45° field of view. Image size 2352x1568. CFP: 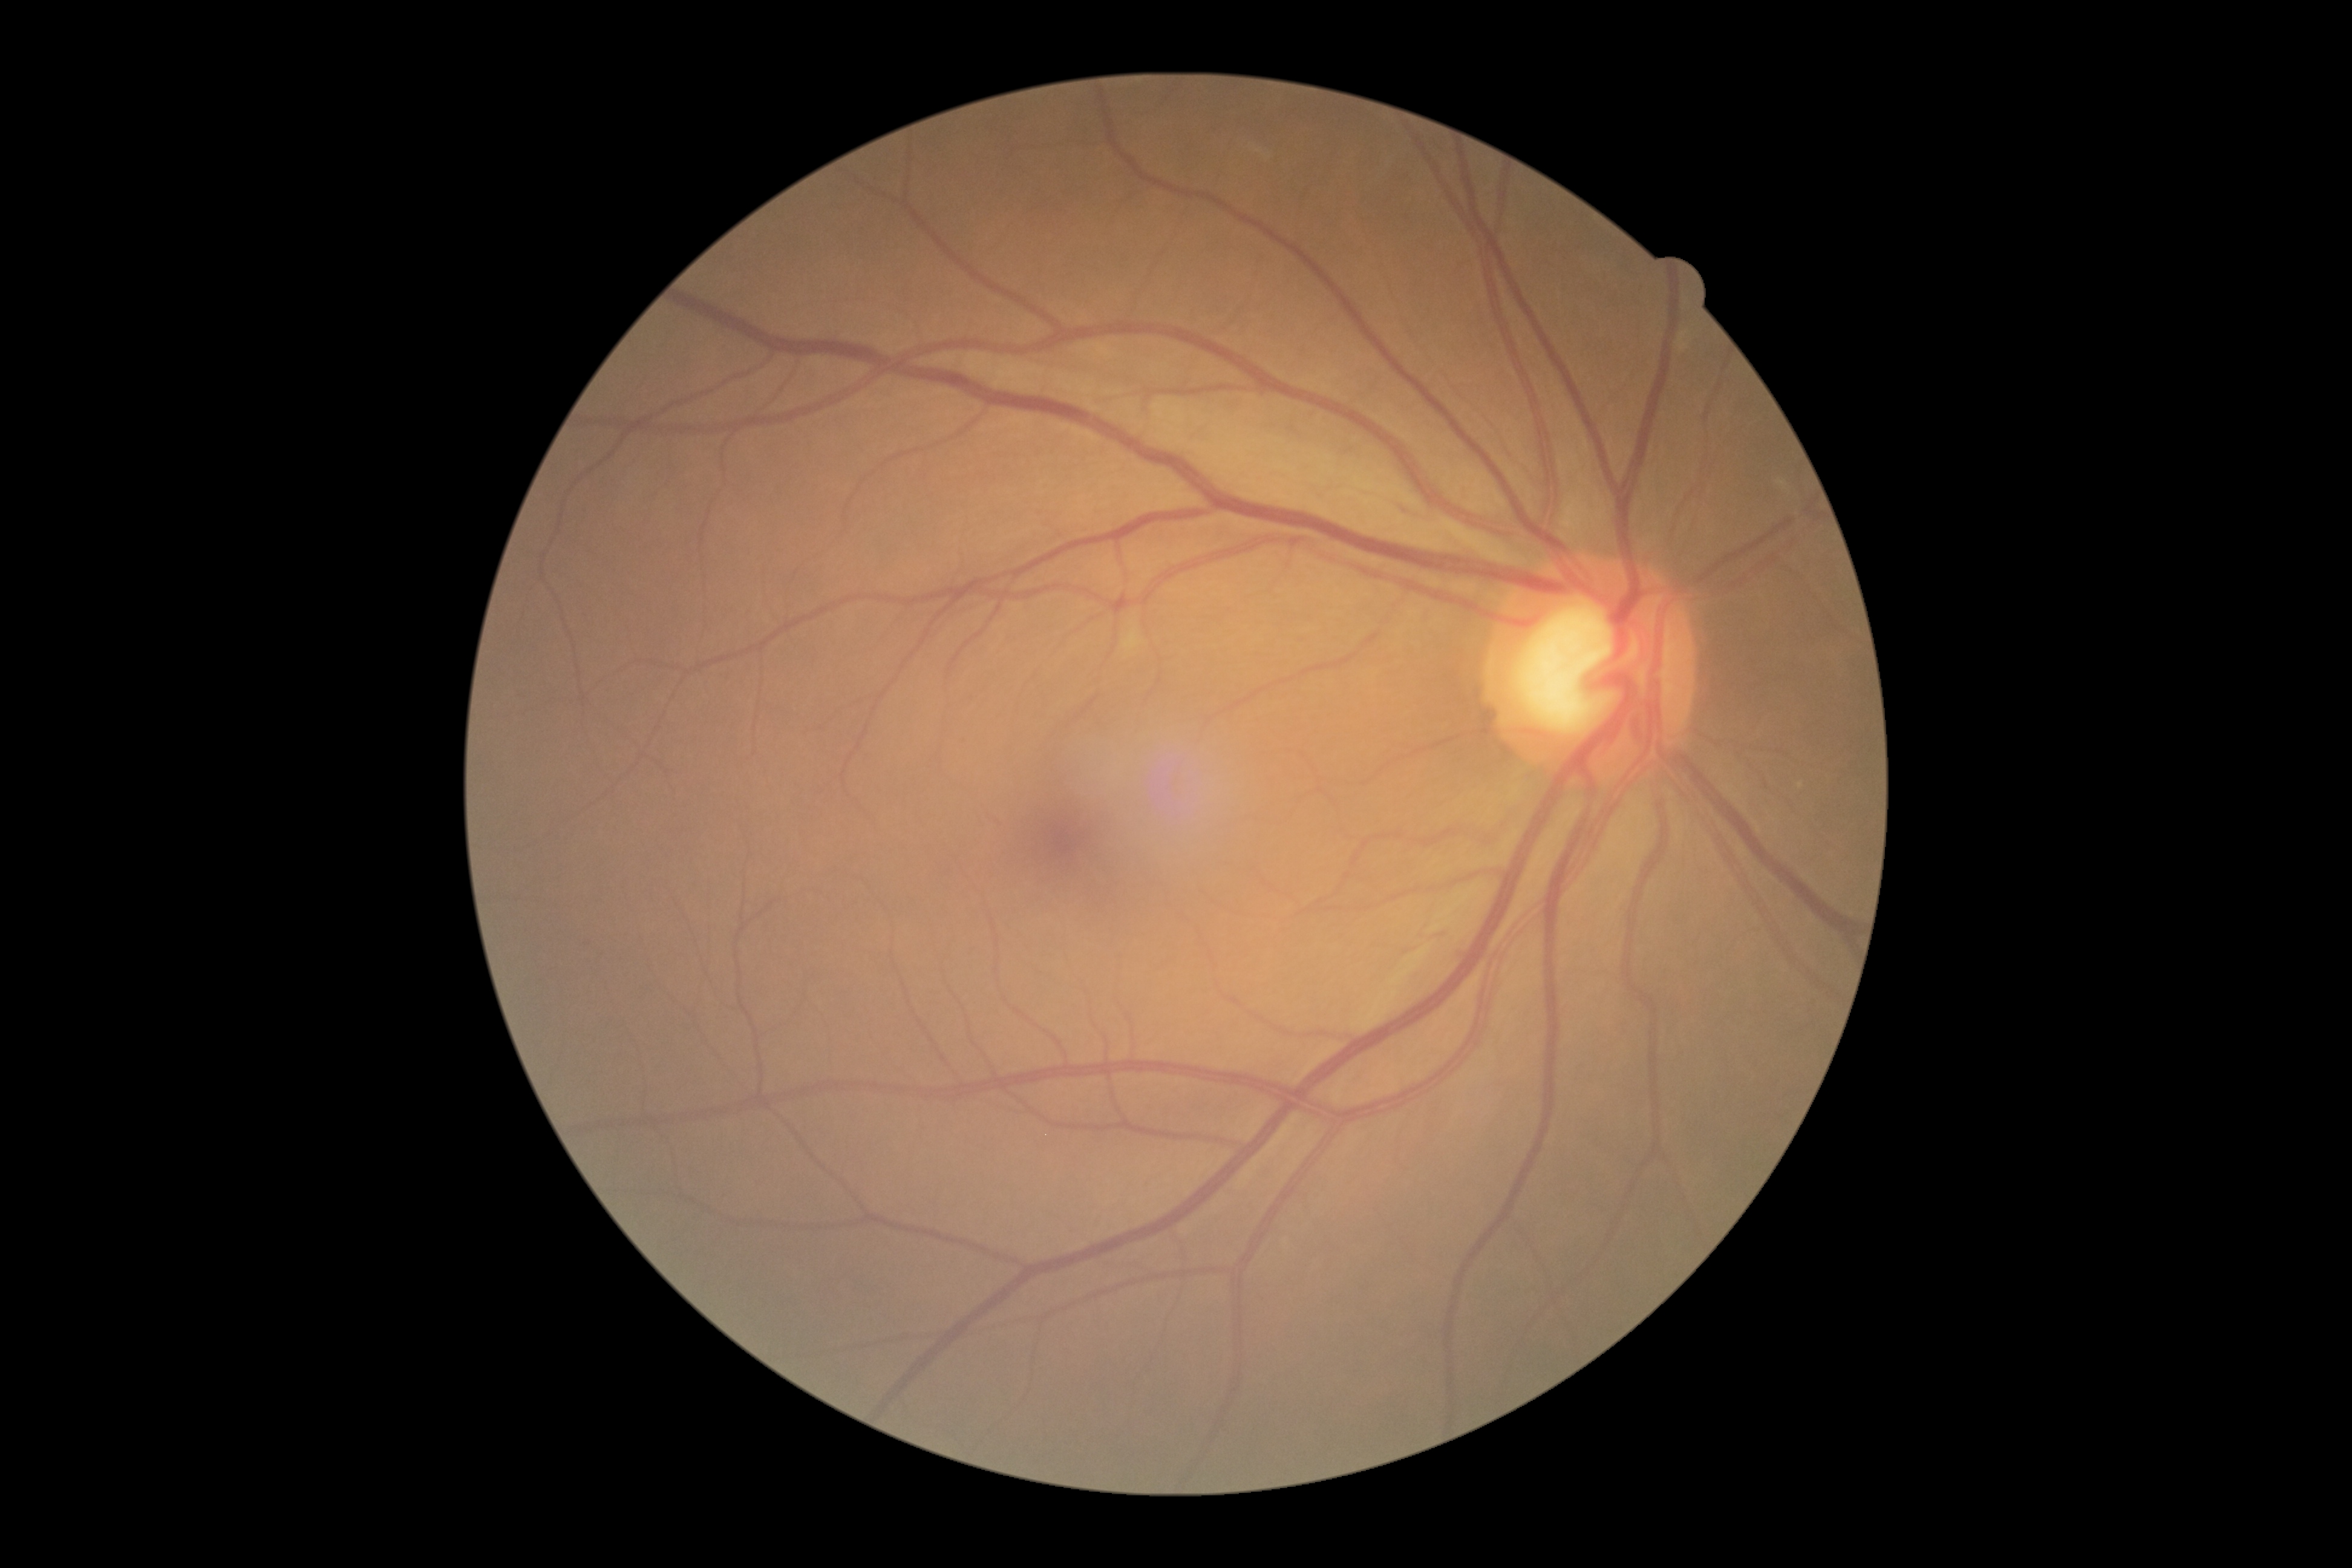

DR stage is 0. No diabetic retinal disease findings.